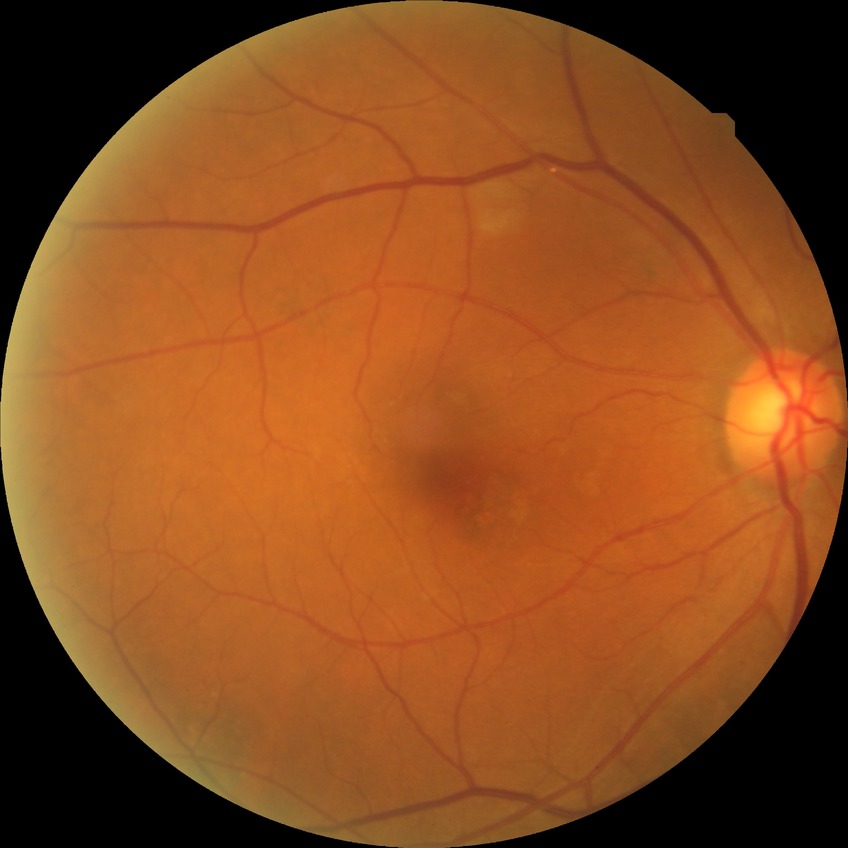 {
  "davis_grade": "no diabetic retinopathy (NDR)"
}